Davis DR grading. 848x848px
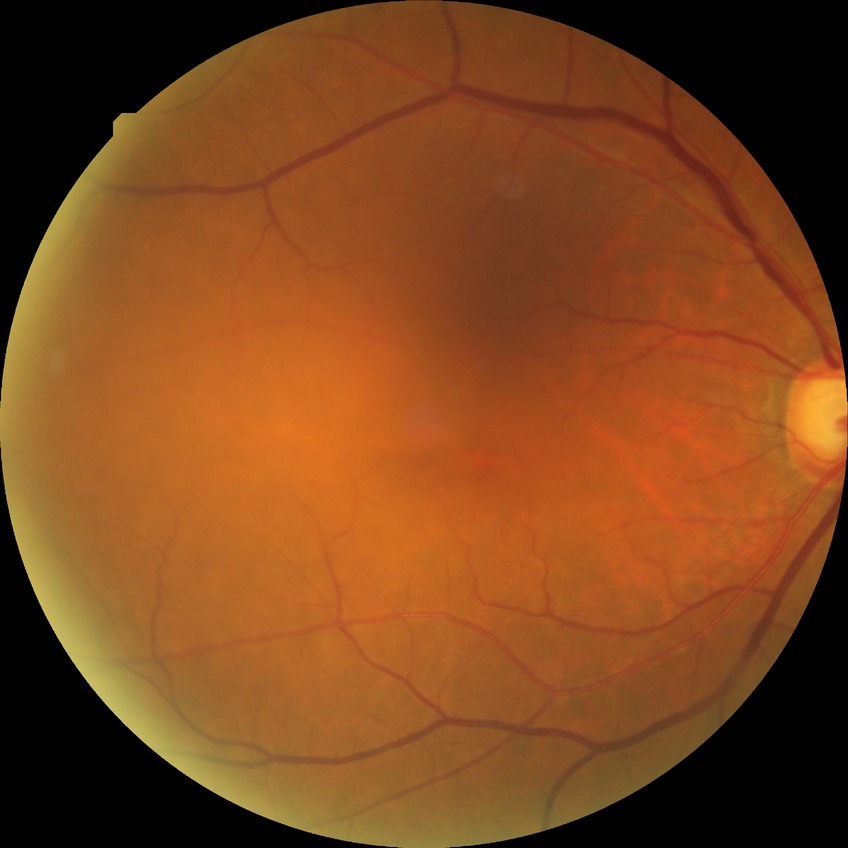 DR class: non-proliferative diabetic retinopathy
DR stage: SDR